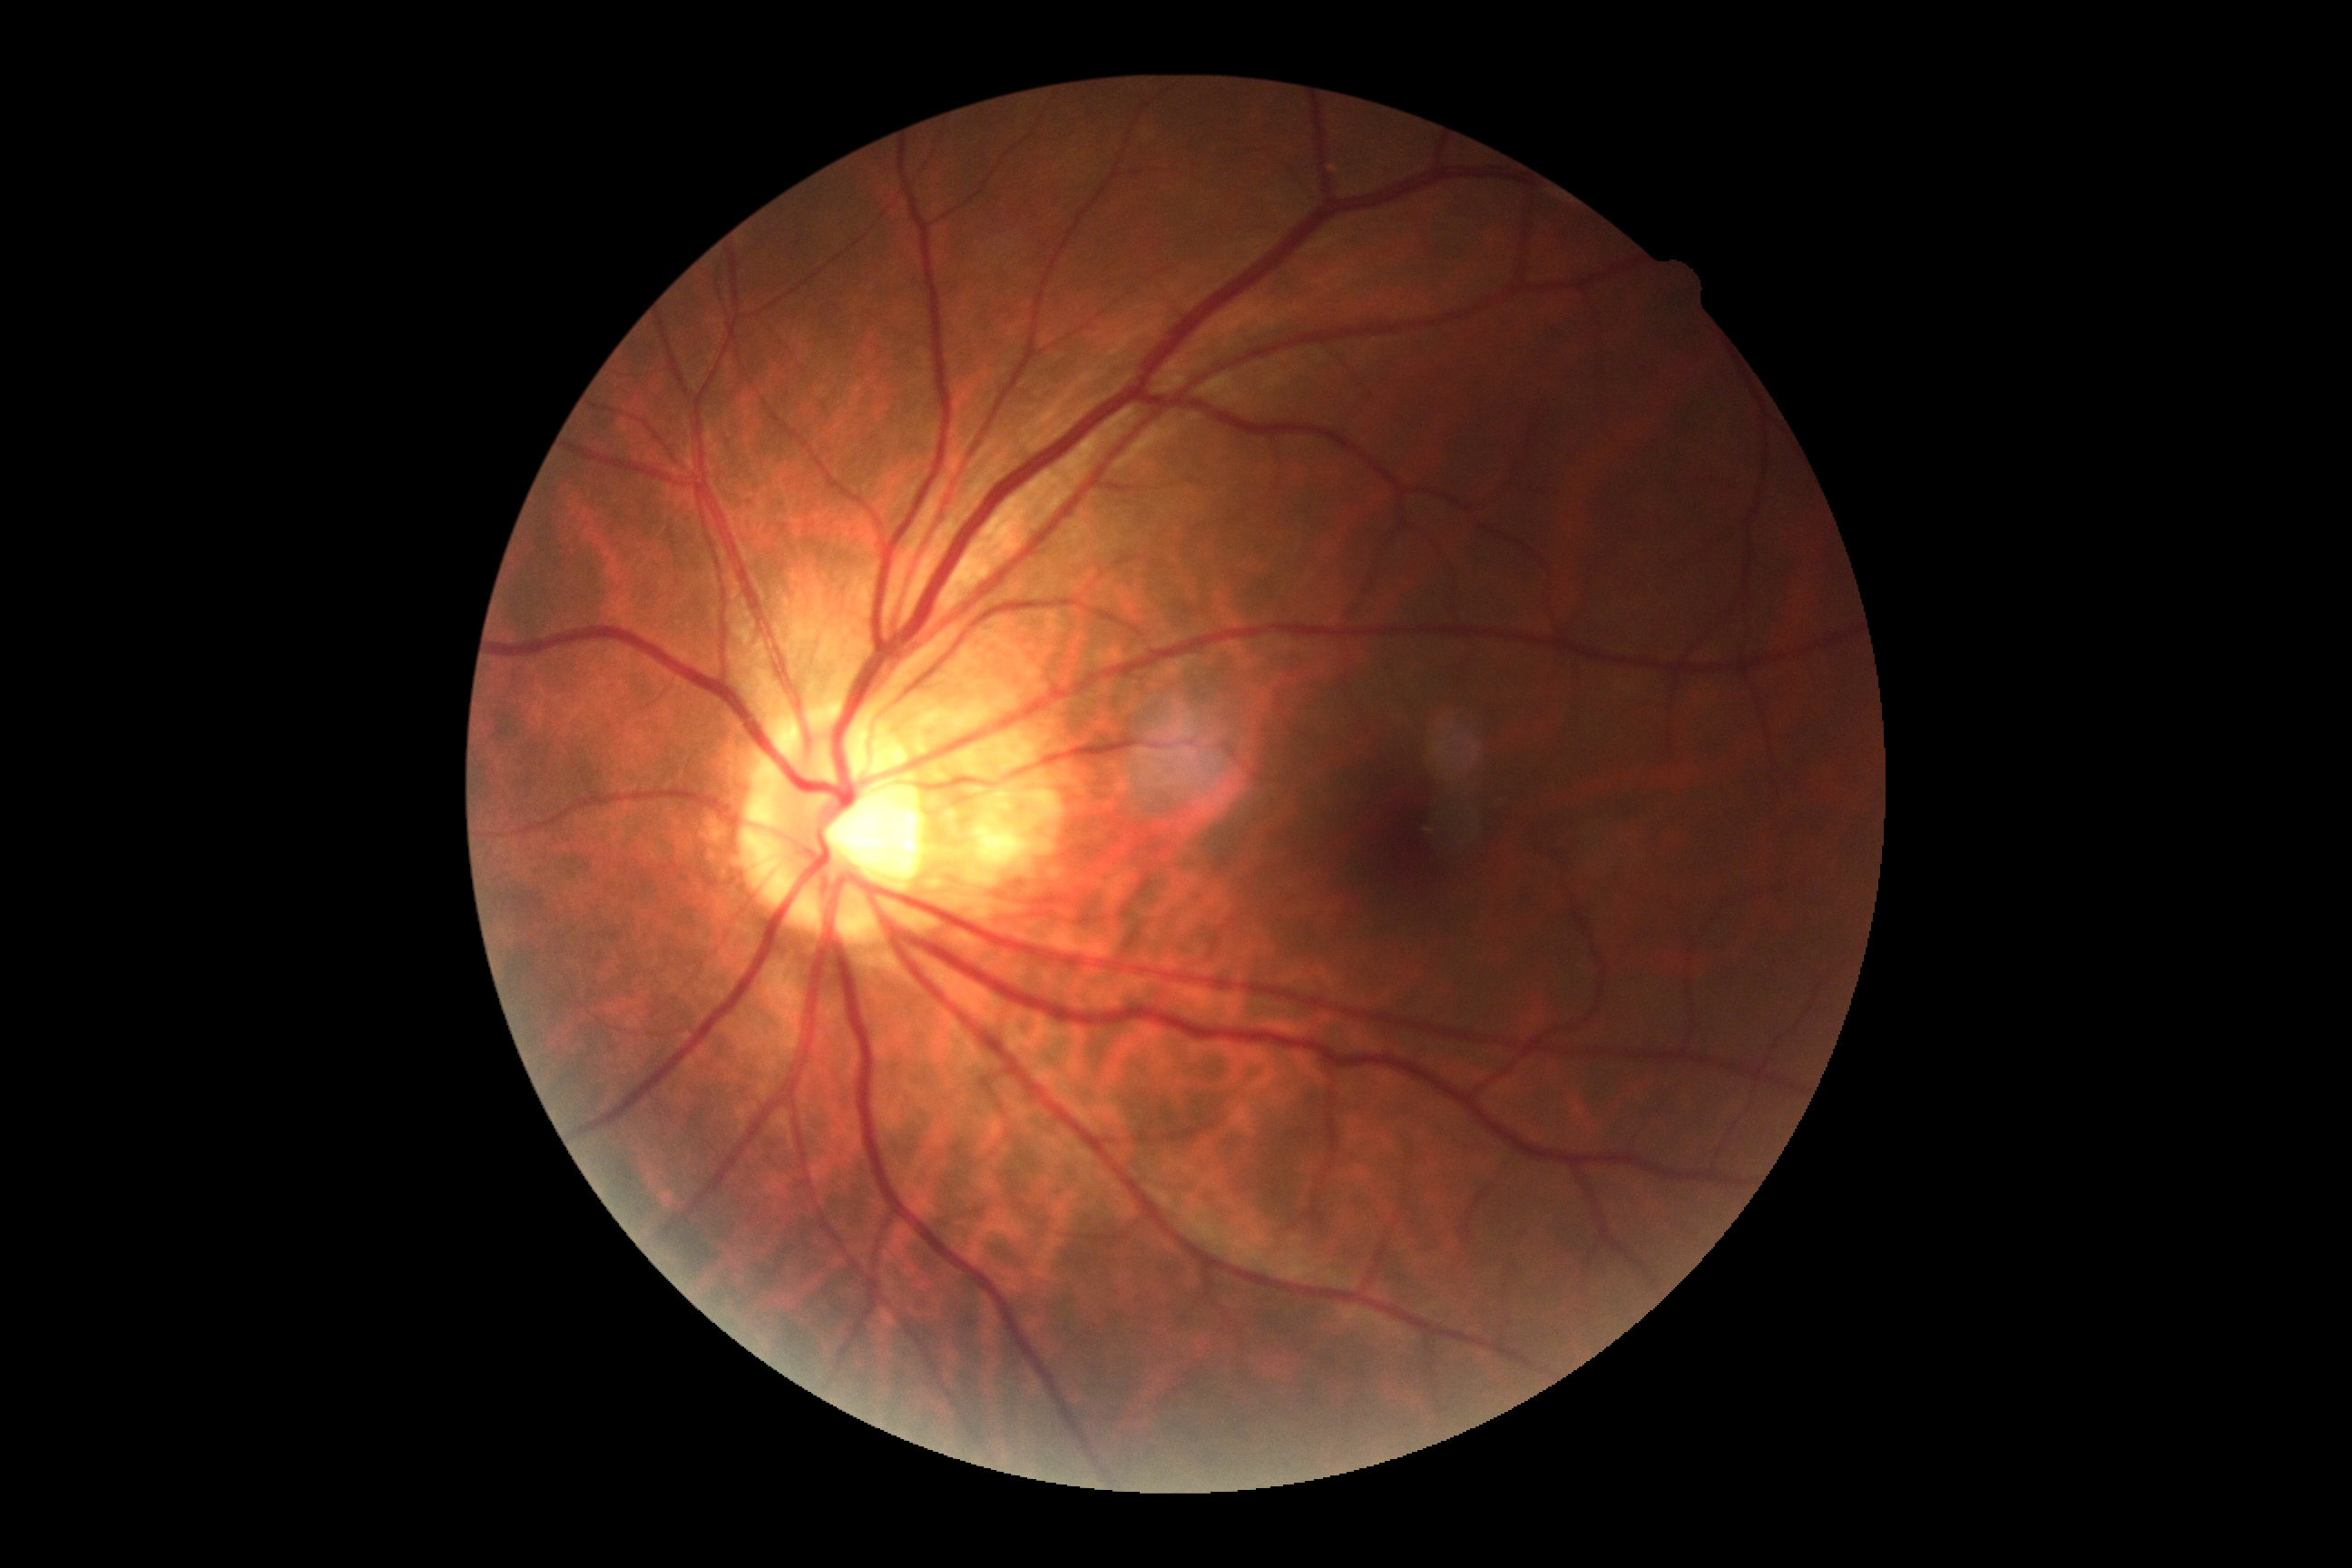
Retinopathy grade: 0 — no visible signs of diabetic retinopathy.